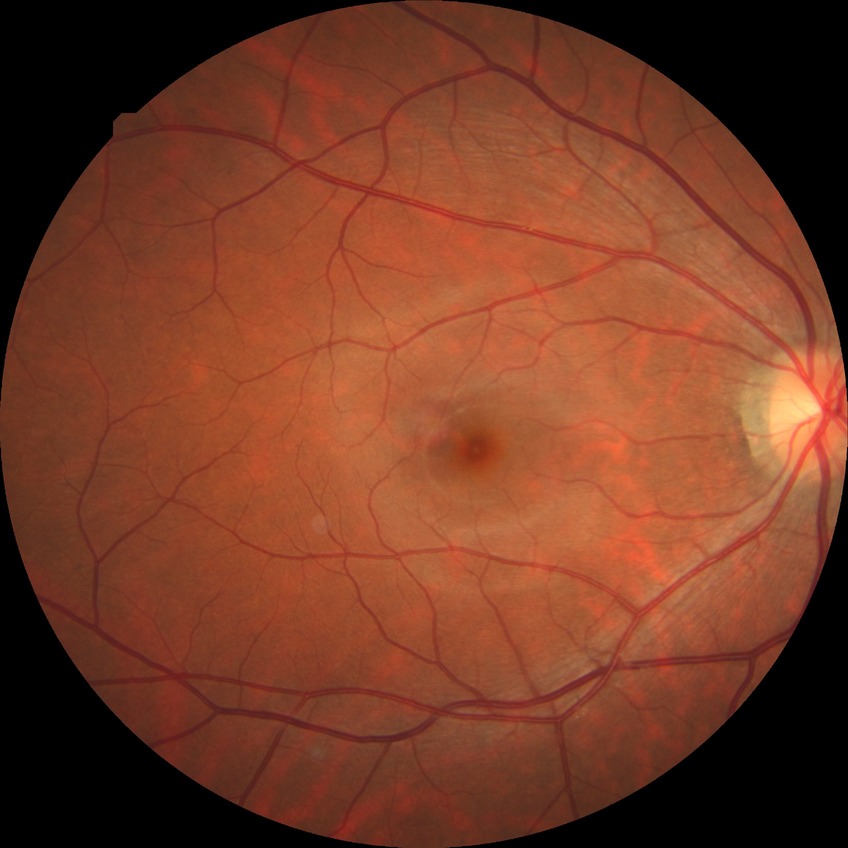
diabetic retinopathy stage: no diabetic retinopathy.